1932 x 1916 pixels:
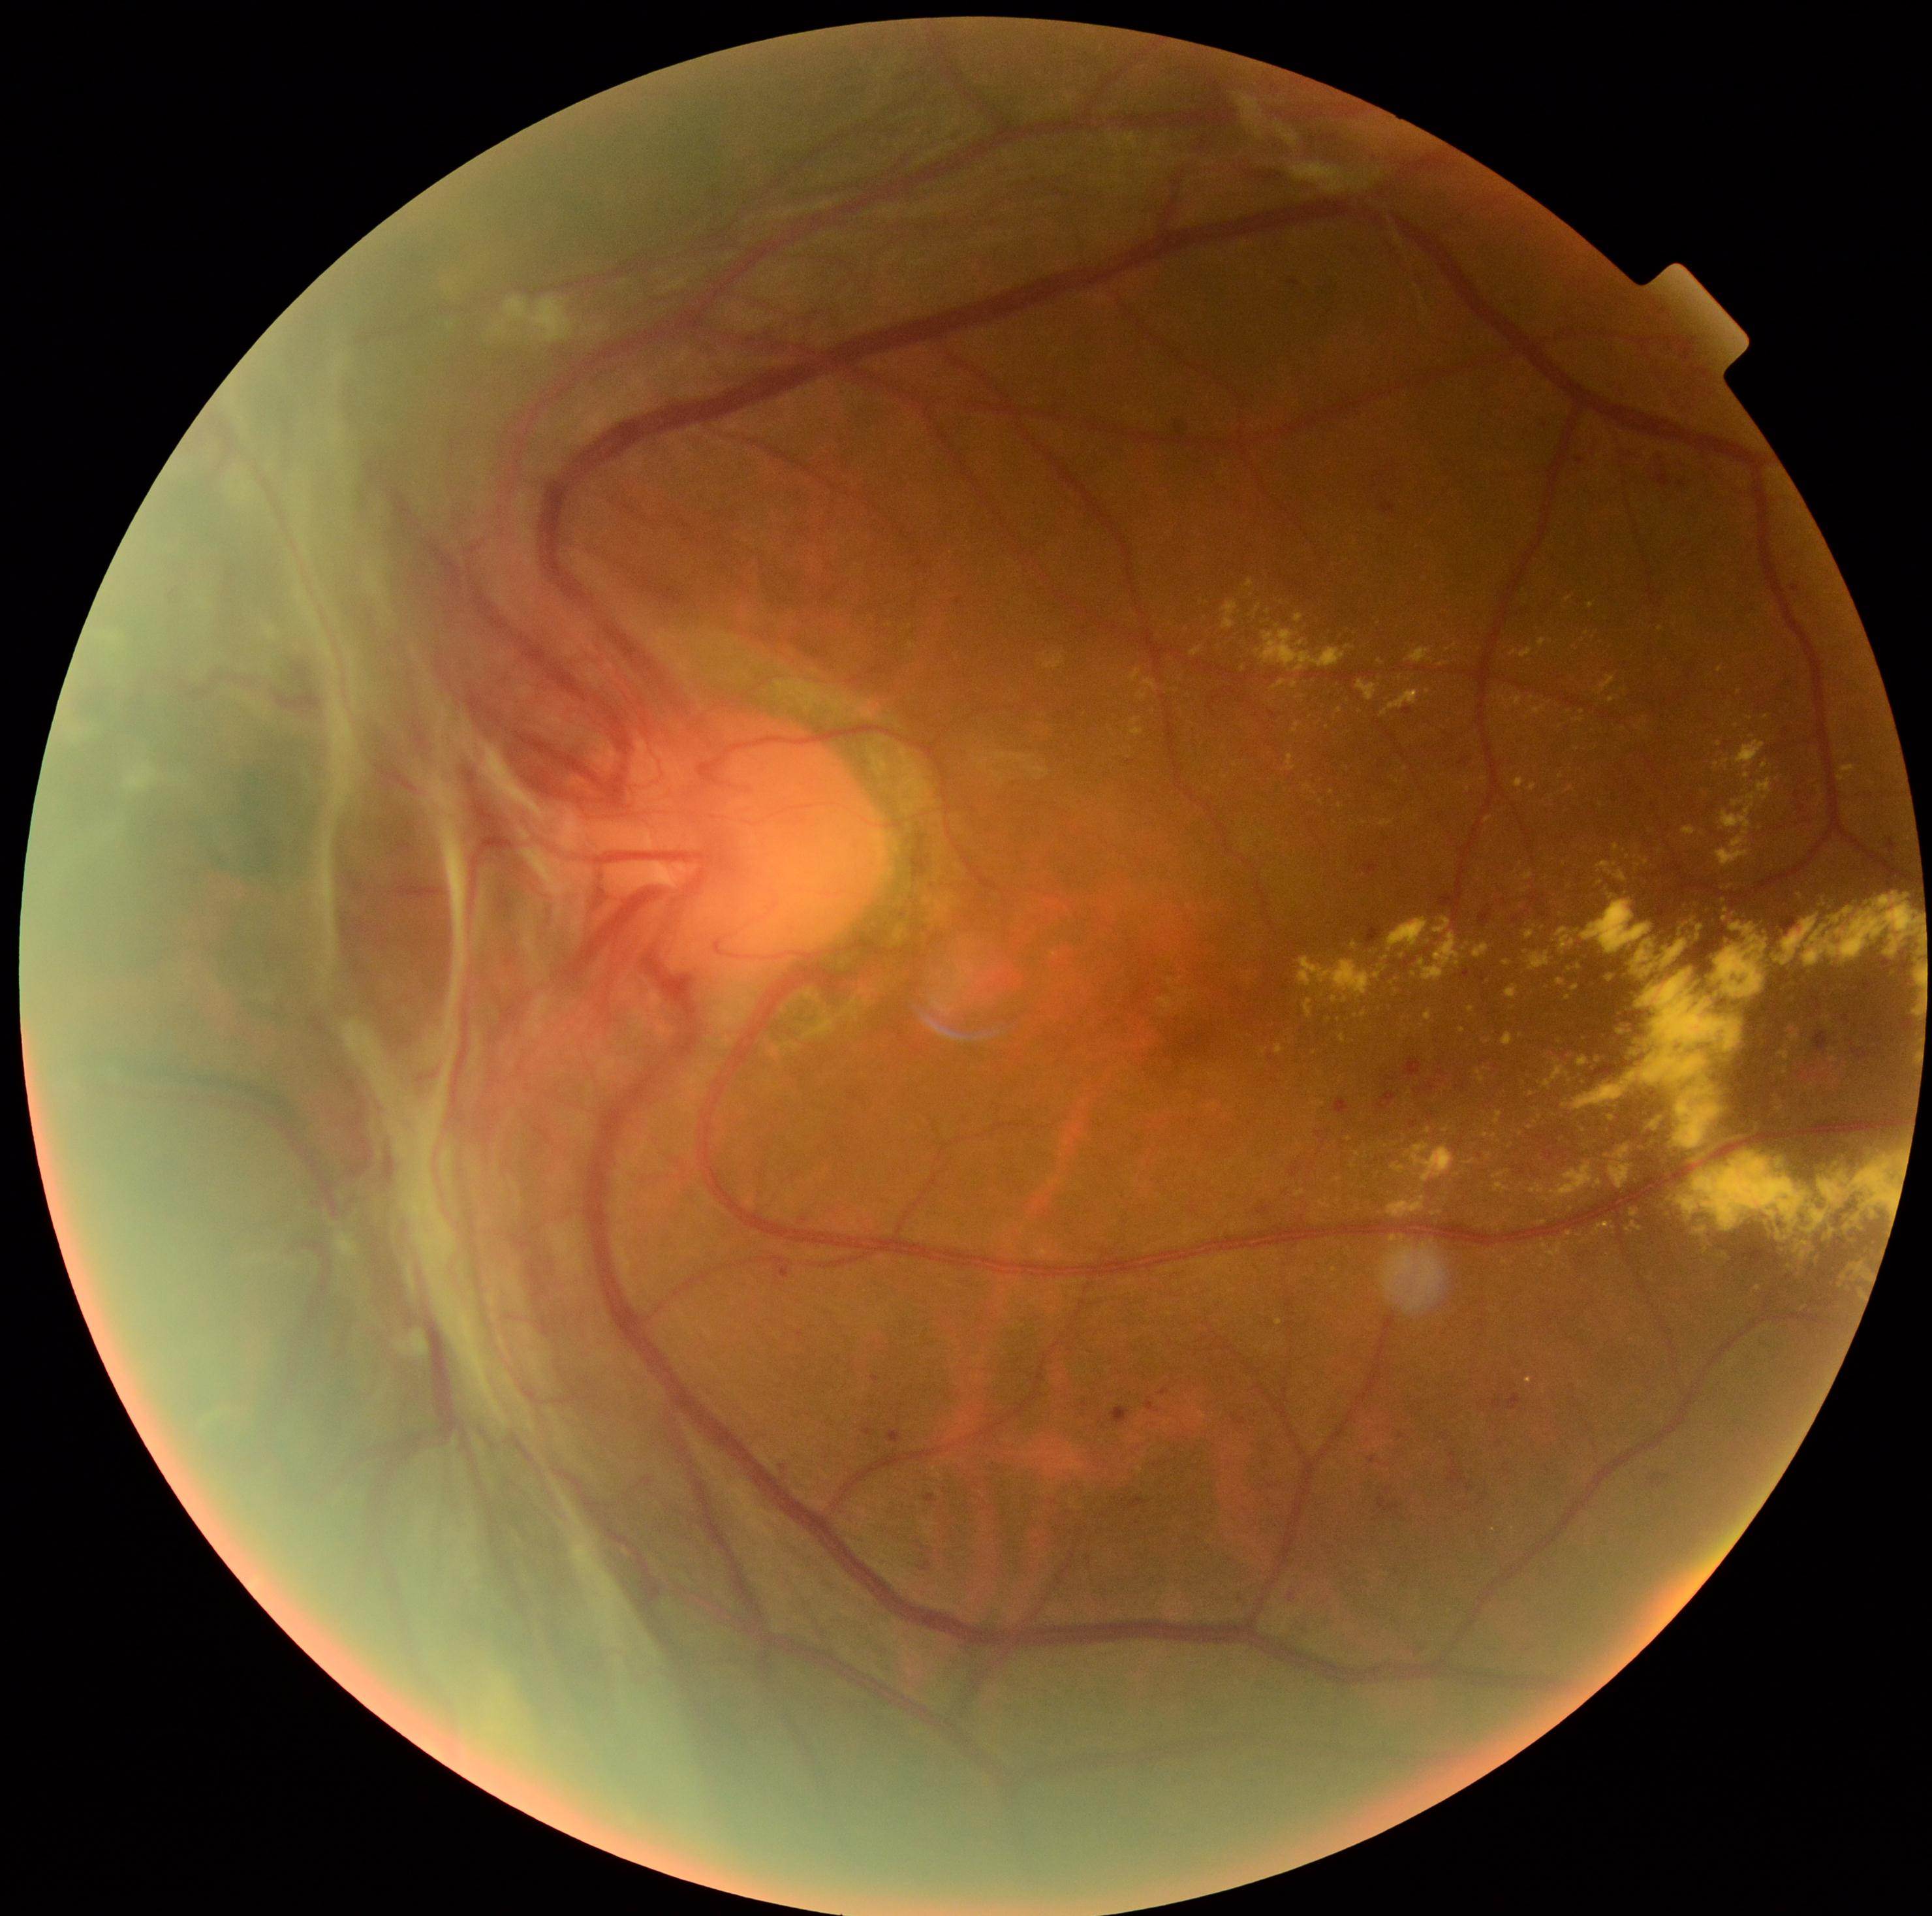

Diabetic retinopathy grade: proliferative diabetic retinopathy (4) — neovascularization and/or vitreous/pre-retinal hemorrhage.